Camera: Topcon TRC-50DX, 2228x1652: 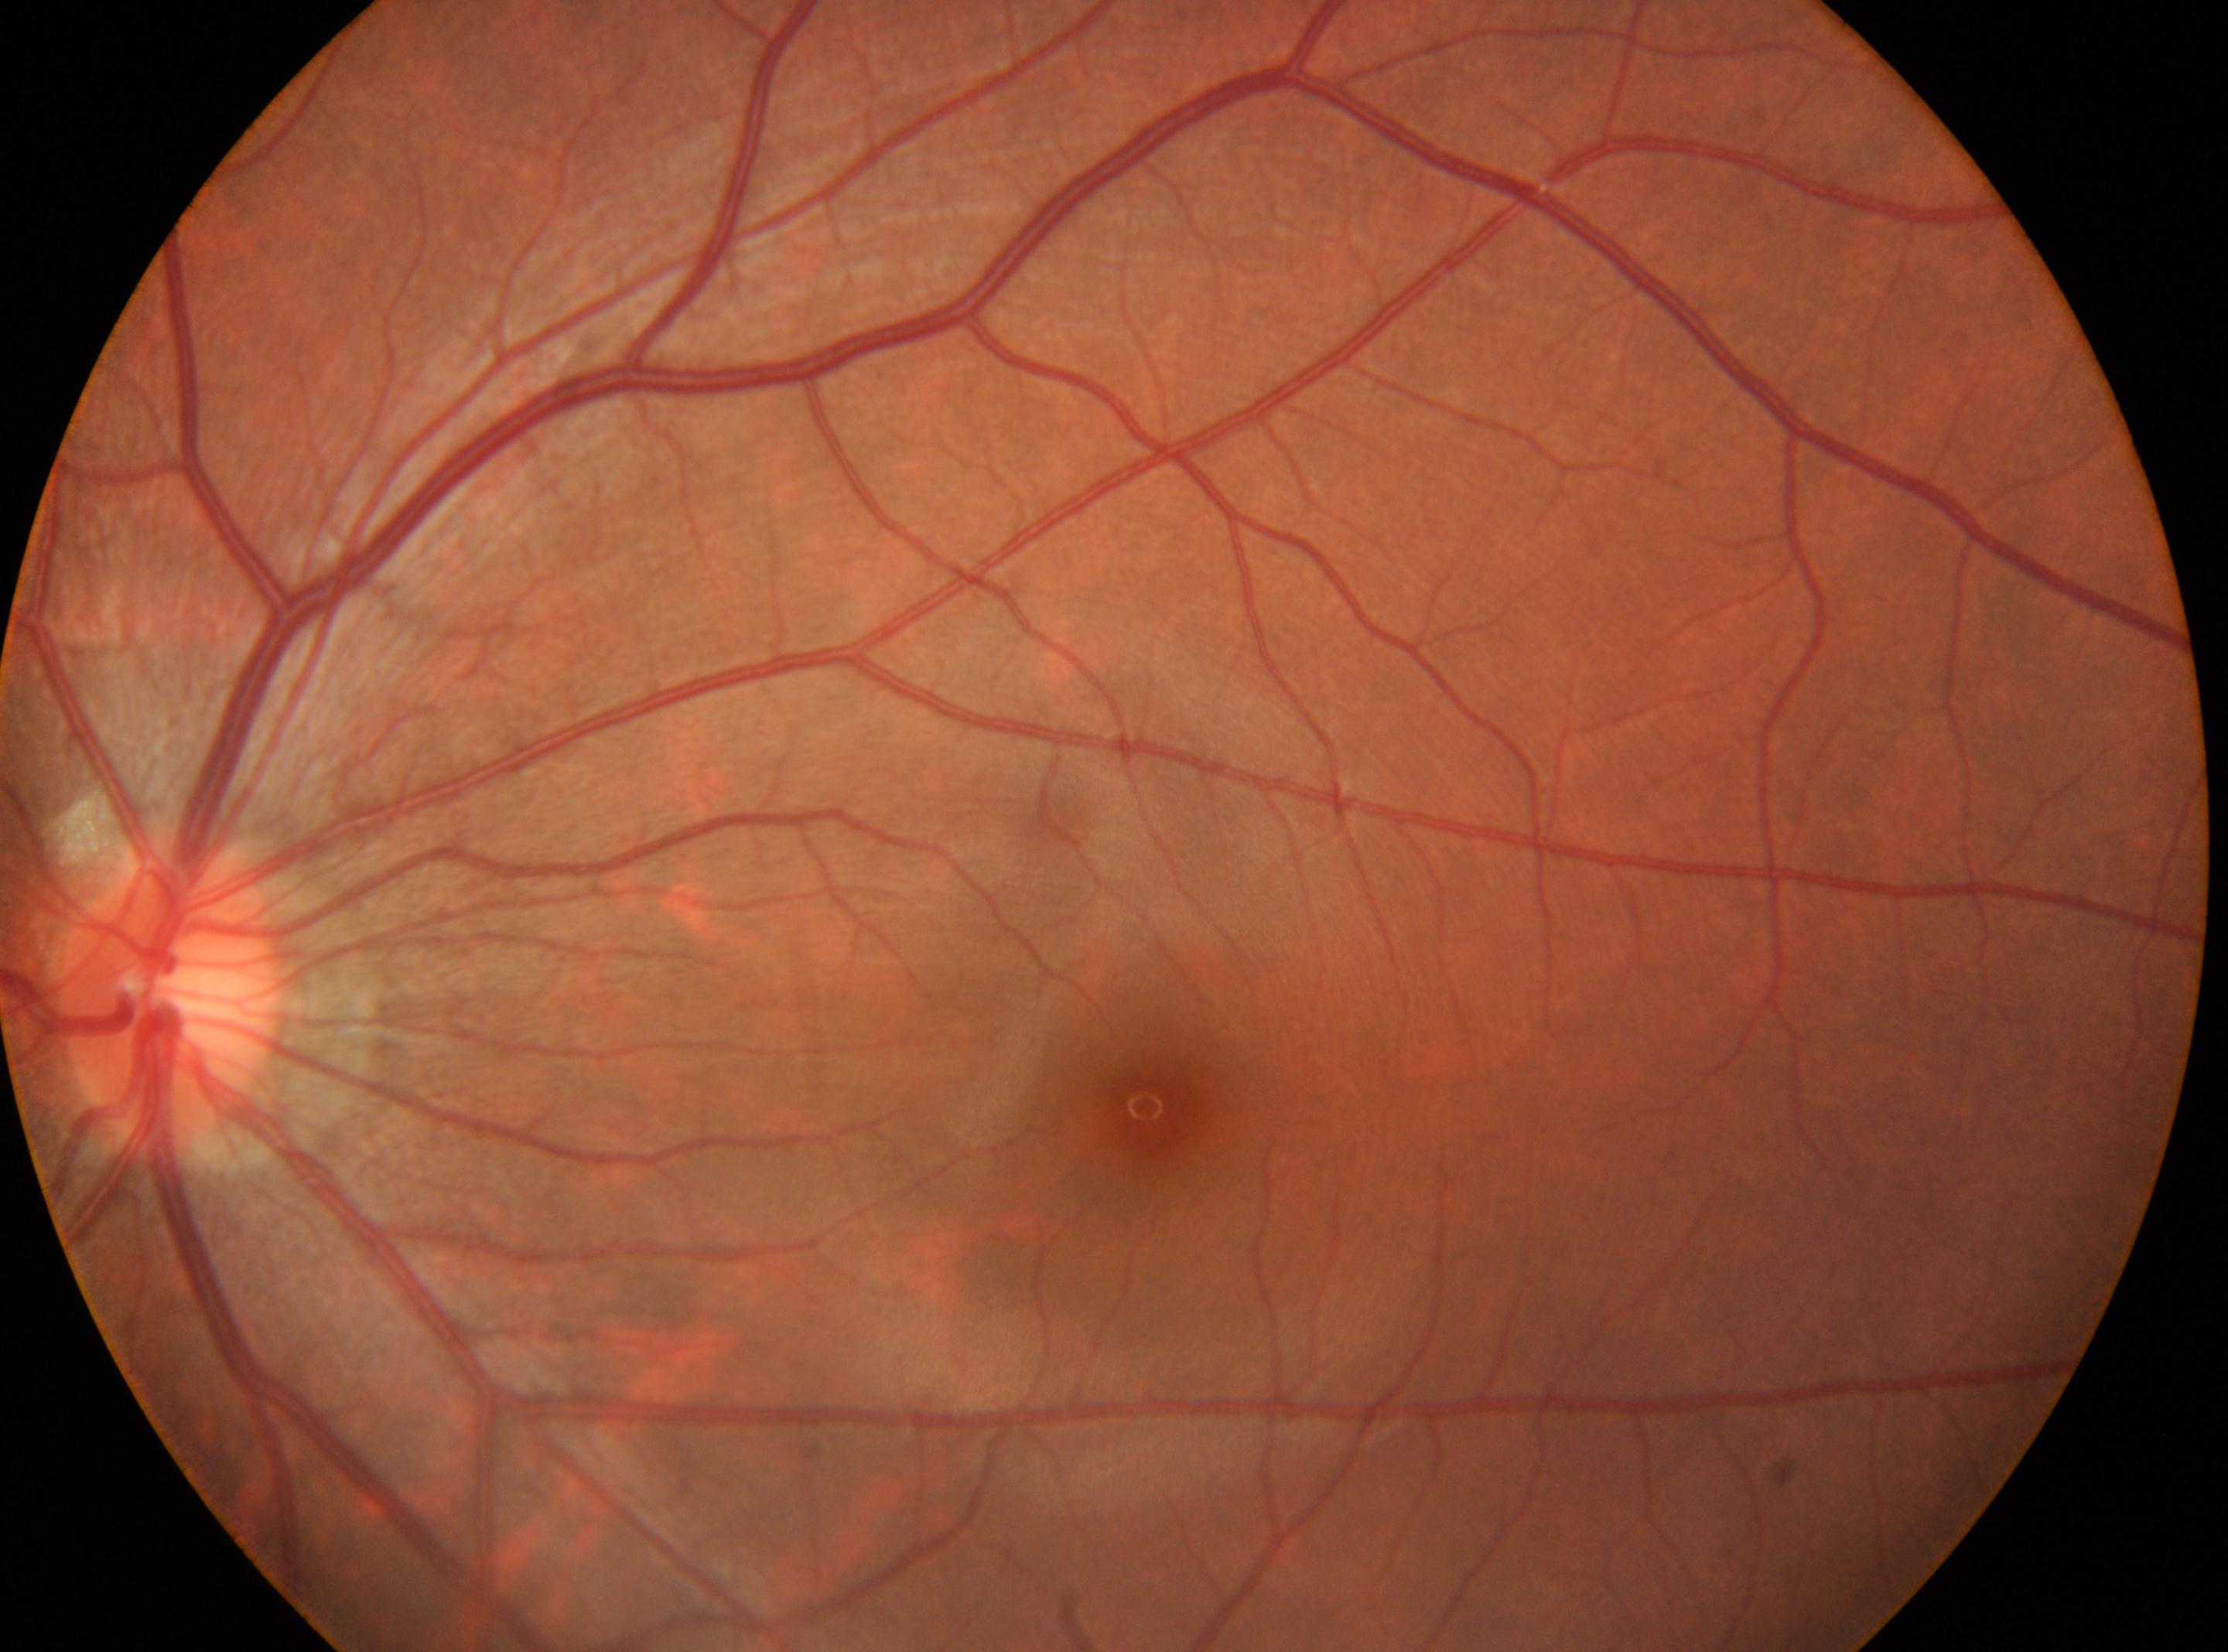 Q: DR stage?
A: no apparent diabetic retinopathy (0)
Q: Optic disc center?
A: 169, 996
Q: Fovea center?
A: 1154, 1109
Q: What is the laterality?
A: OS